640x480px. Wide-field contact fundus photograph of an infant.
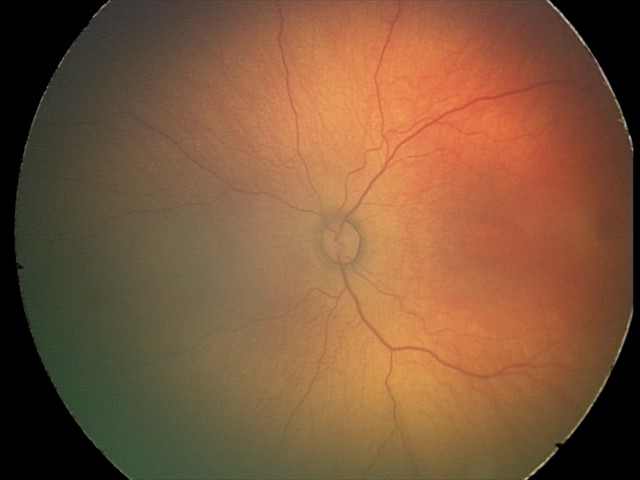 From an examination with diagnosis of status post retinopathy of prematurity (ROP).